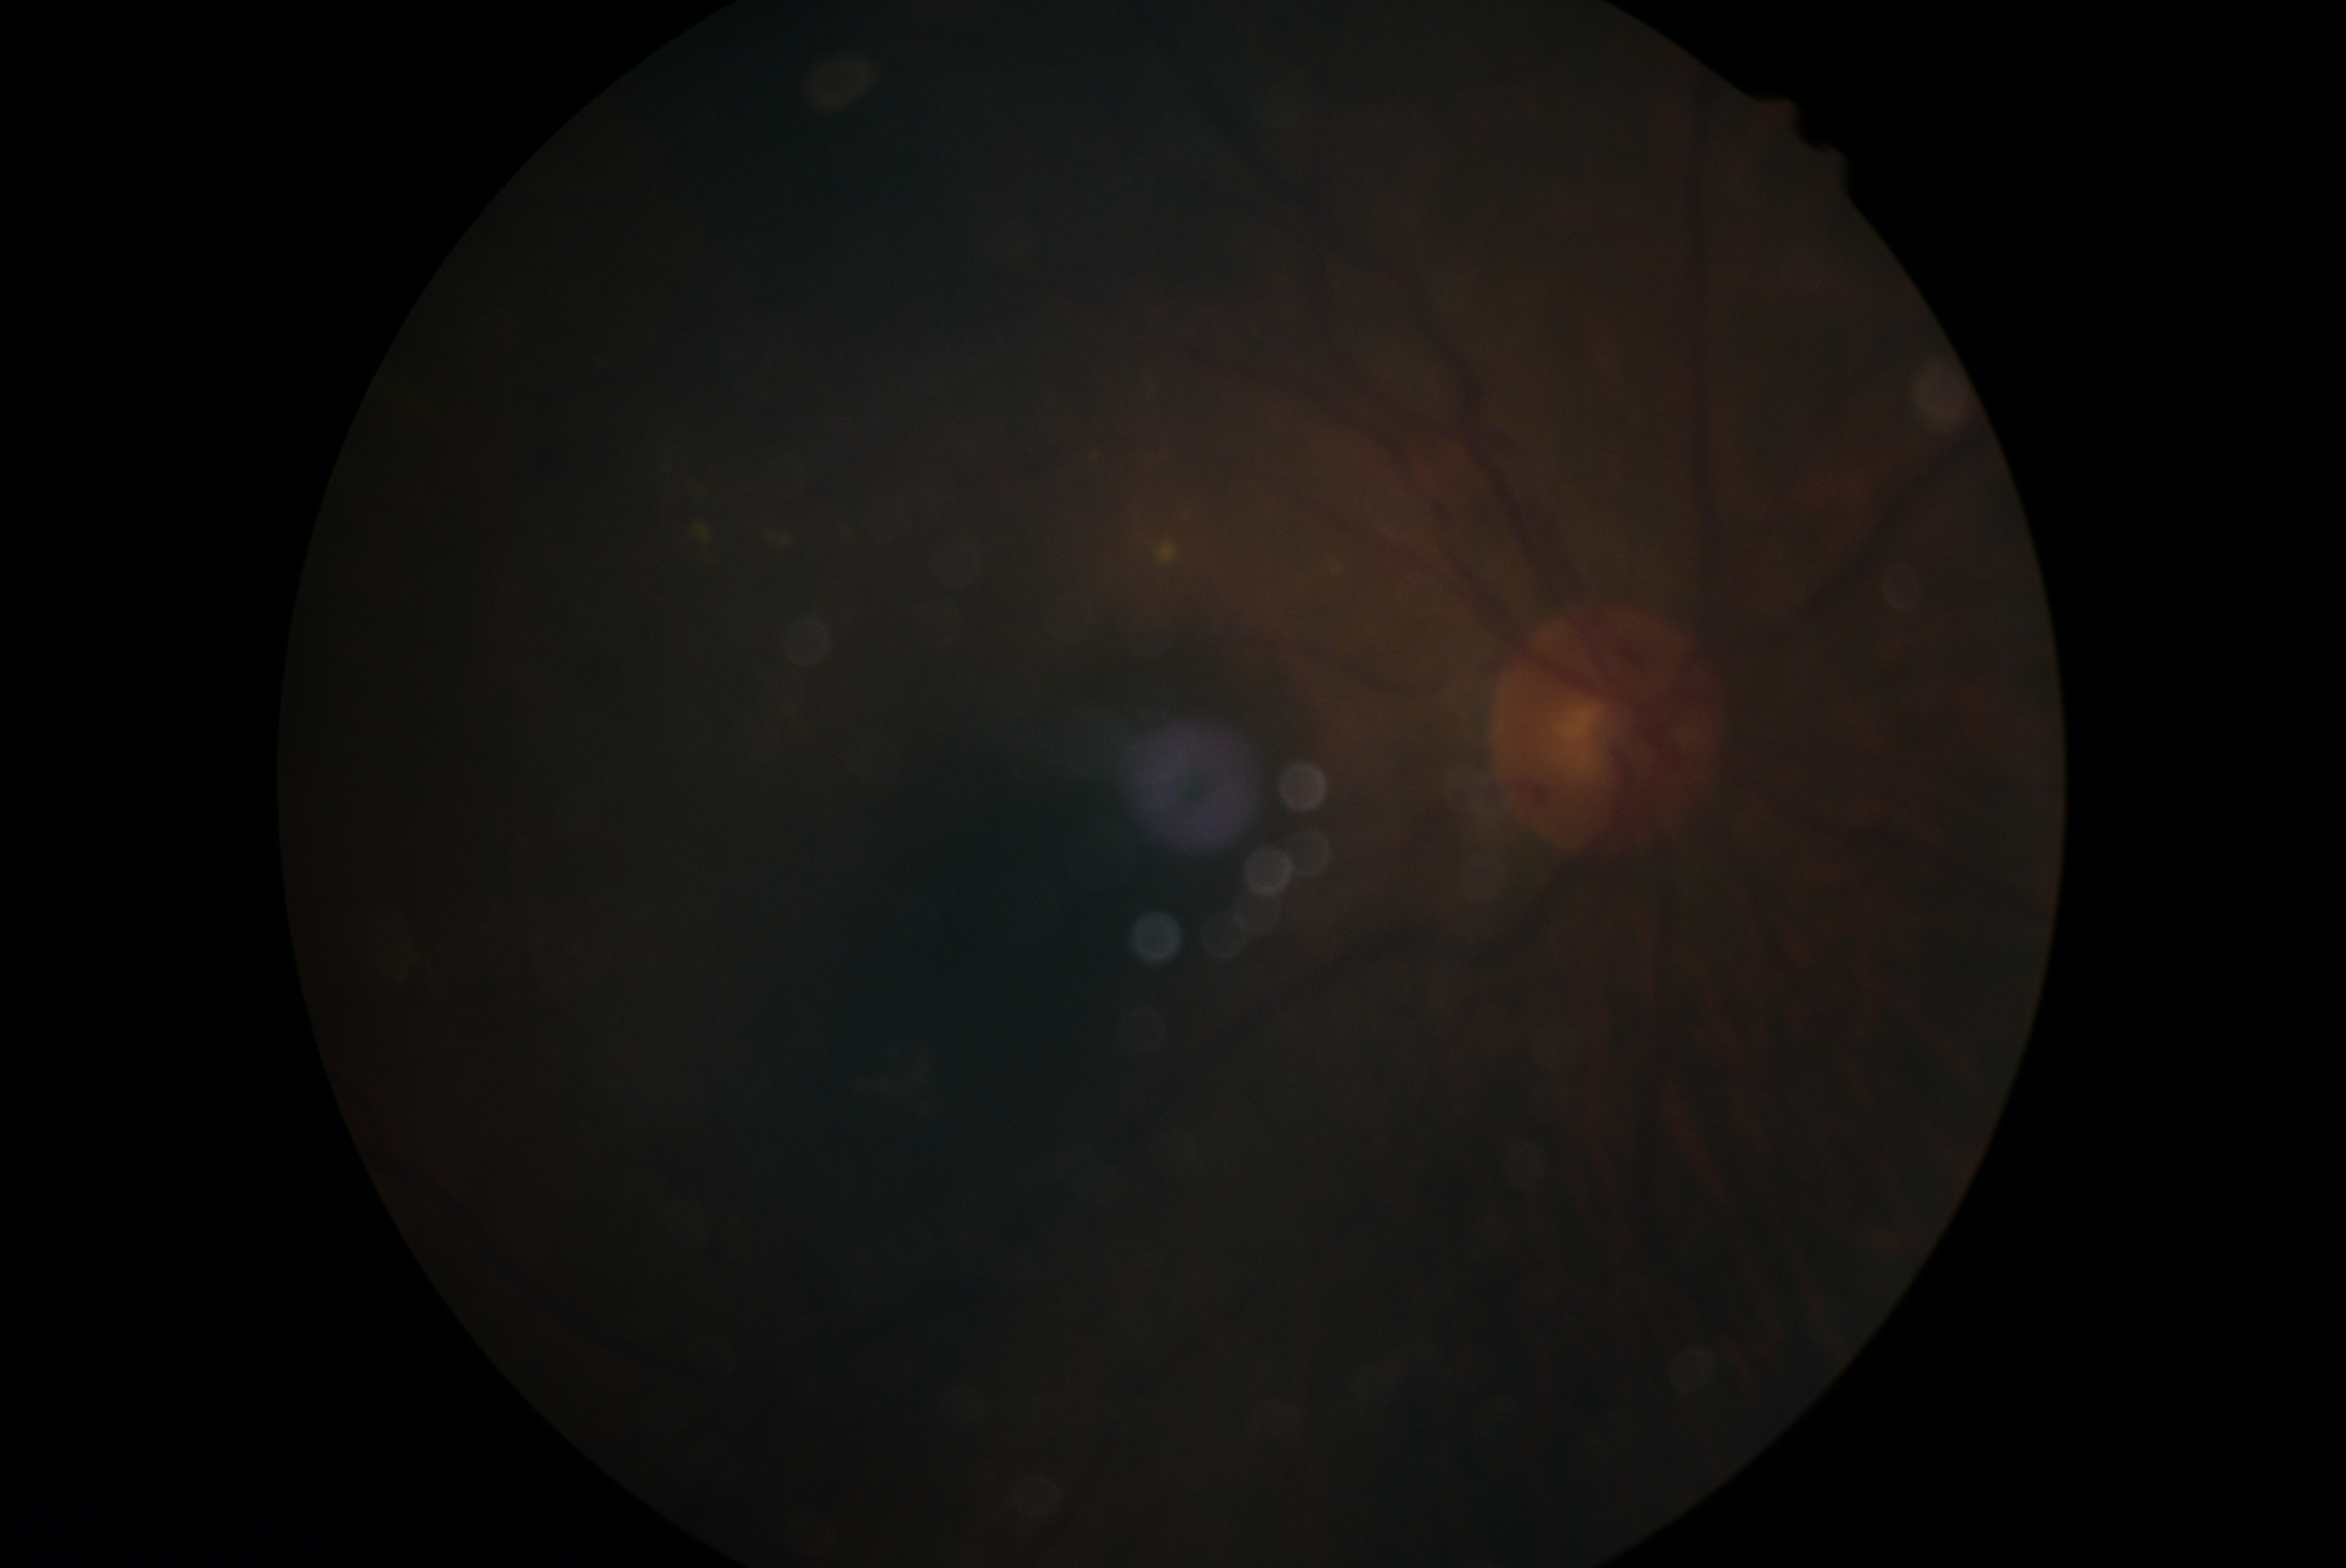 Diabetic retinopathy (DR) is grade 2.